Pediatric wide-field fundus photograph. Acquired on the Clarity RetCam 3: 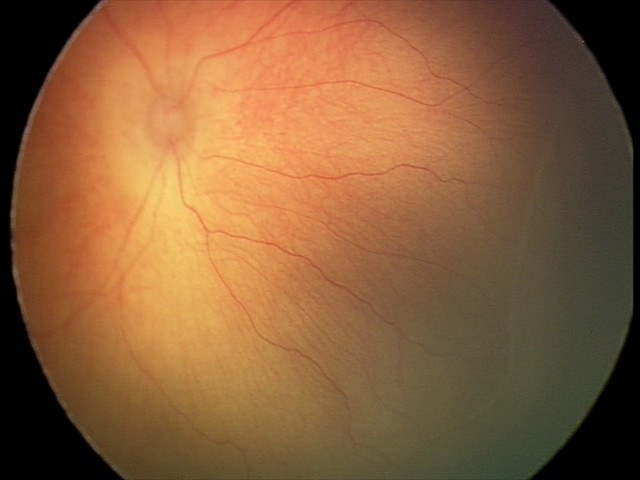

Q: What is the plus-form classification?
A: no plus disease
Q: What was the screening finding?
A: retinopathy of prematurity (ROP) stage 2